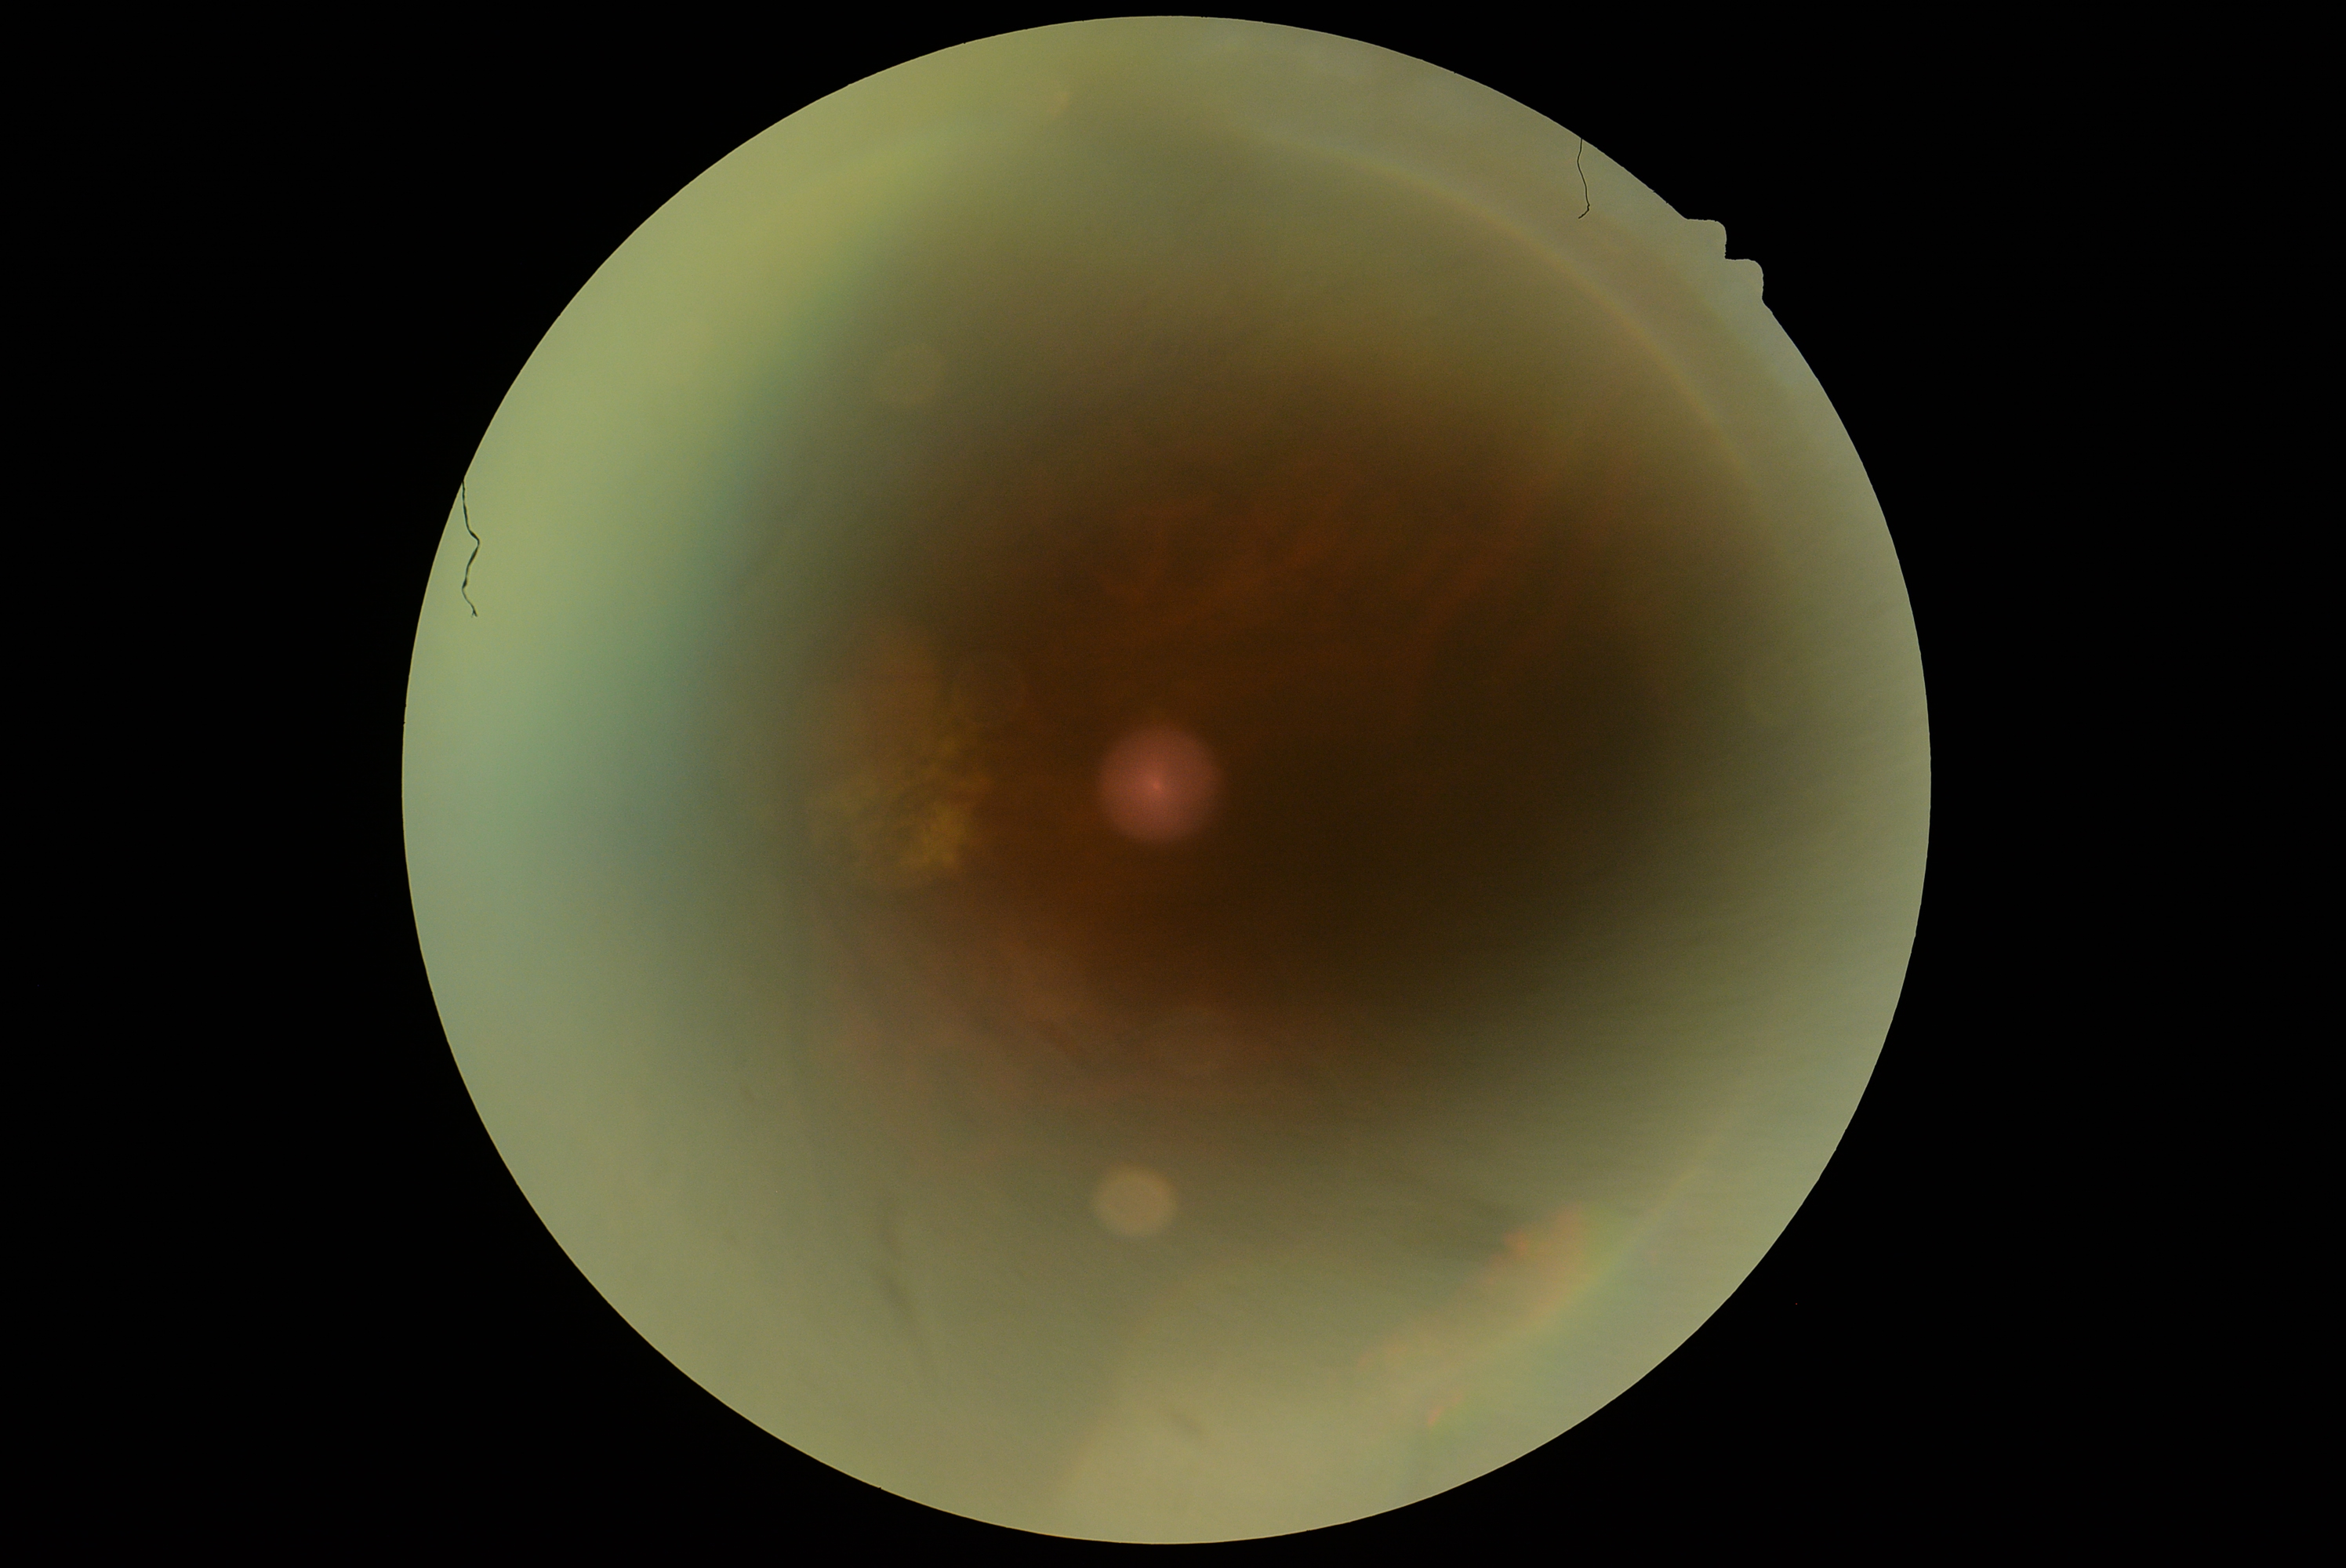 diabetic retinopathy grade: ungradable due to poor image quality.